Modified Davis classification.
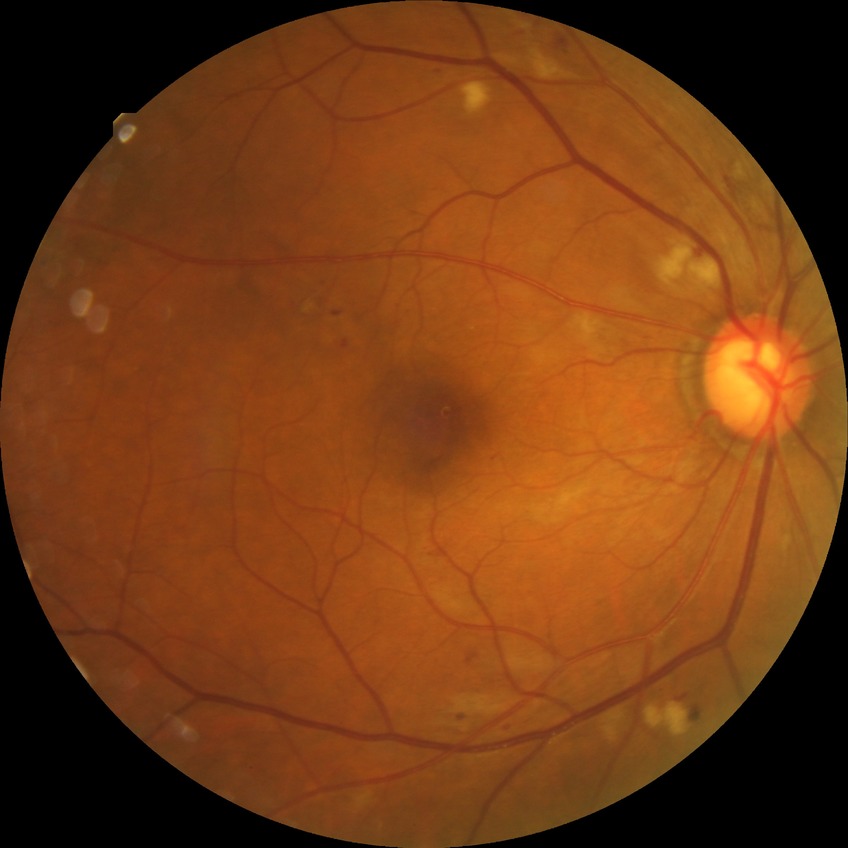
Diabetic retinopathy (DR): pre-proliferative diabetic retinopathy (PPDR).